1440x1080px · wide-field fundus image from infant ROP screening · 130° field of view (Natus RetCam Envision).
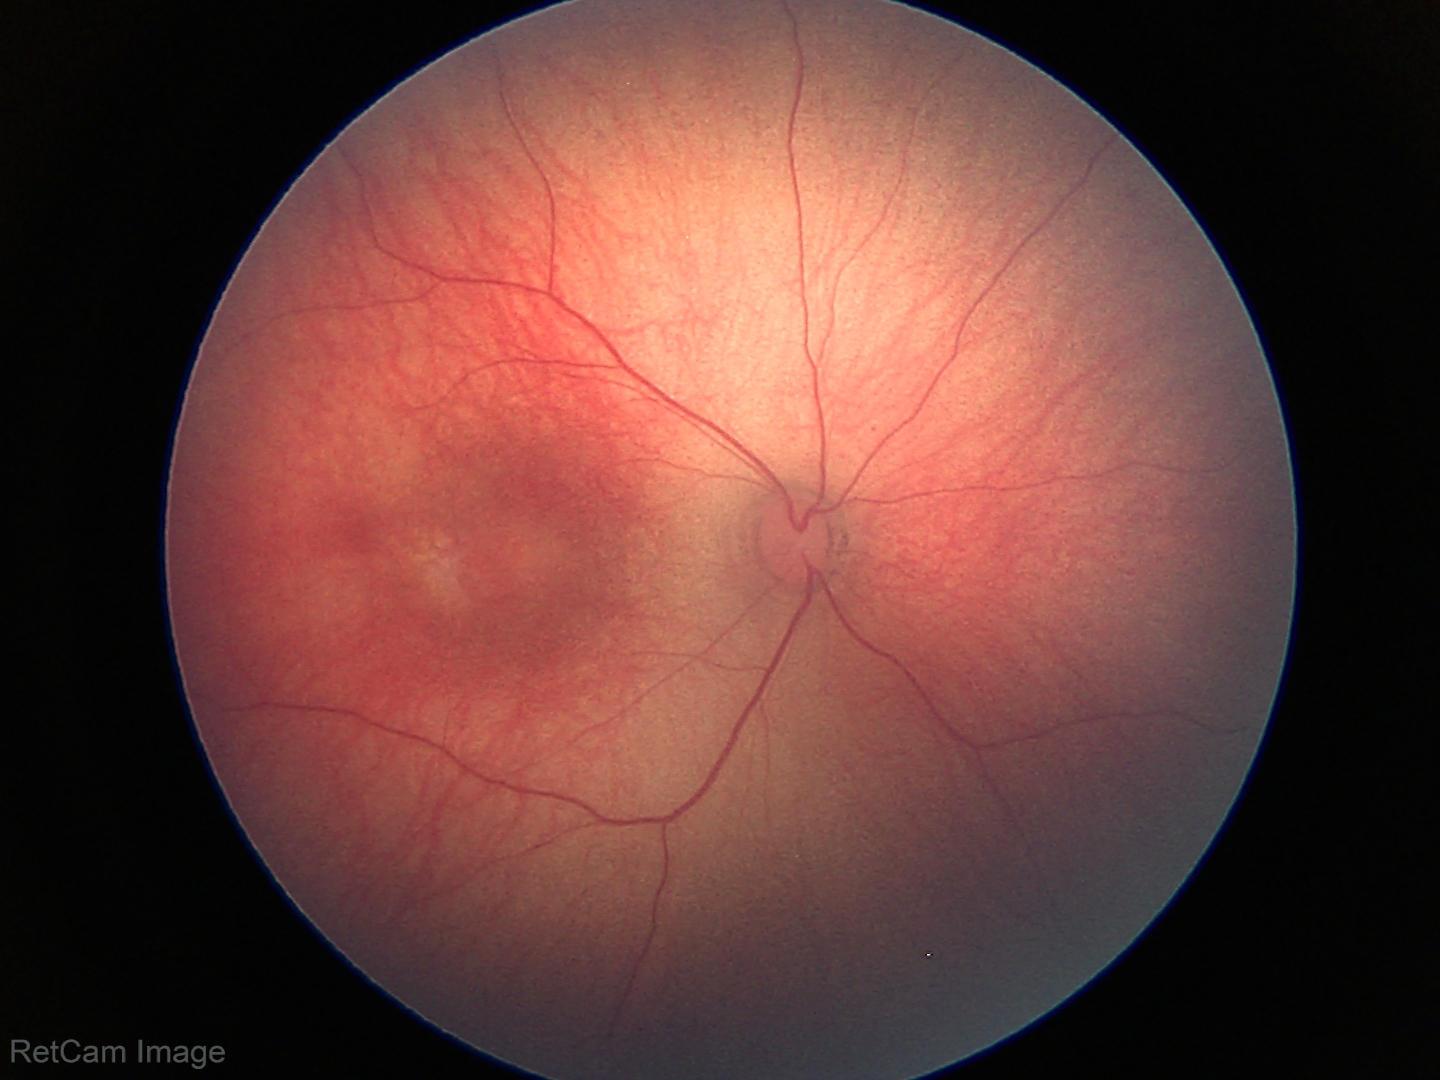 Screening examination with no abnormal retinal findings.